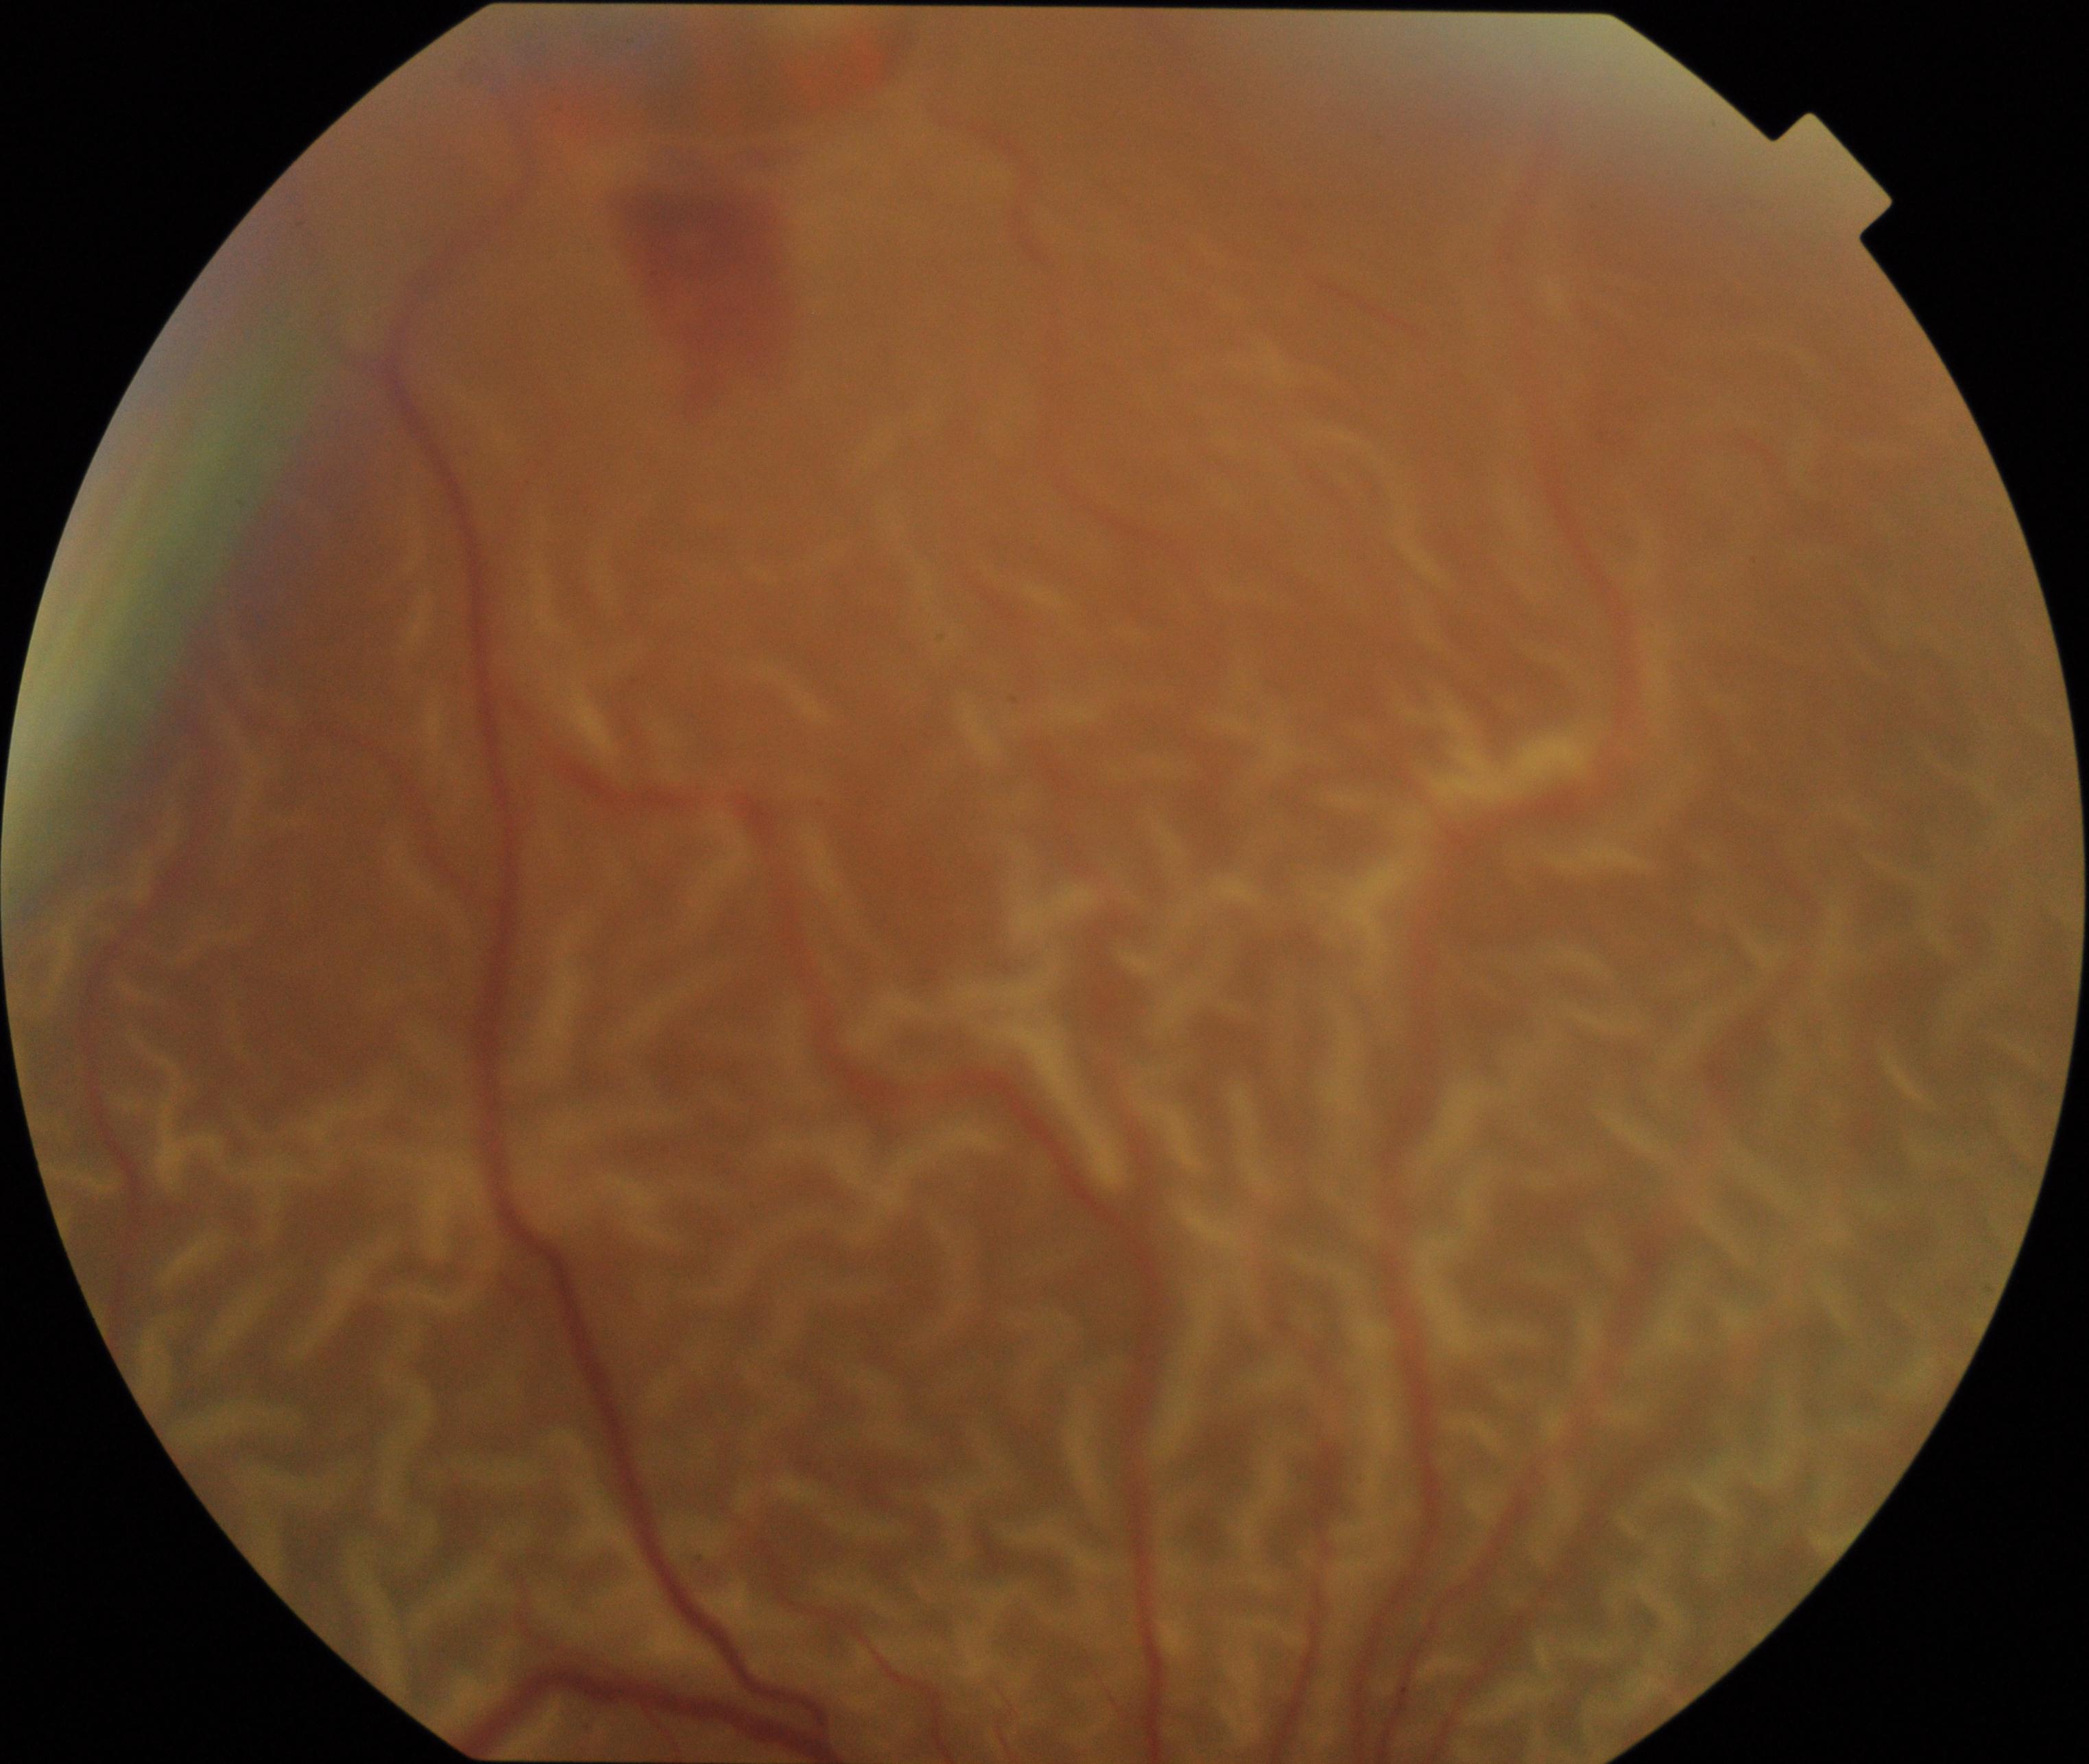
Findings: rhegmatogenous retinal detachment.